Color fundus image, 2048x1536px, 45-degree field of view
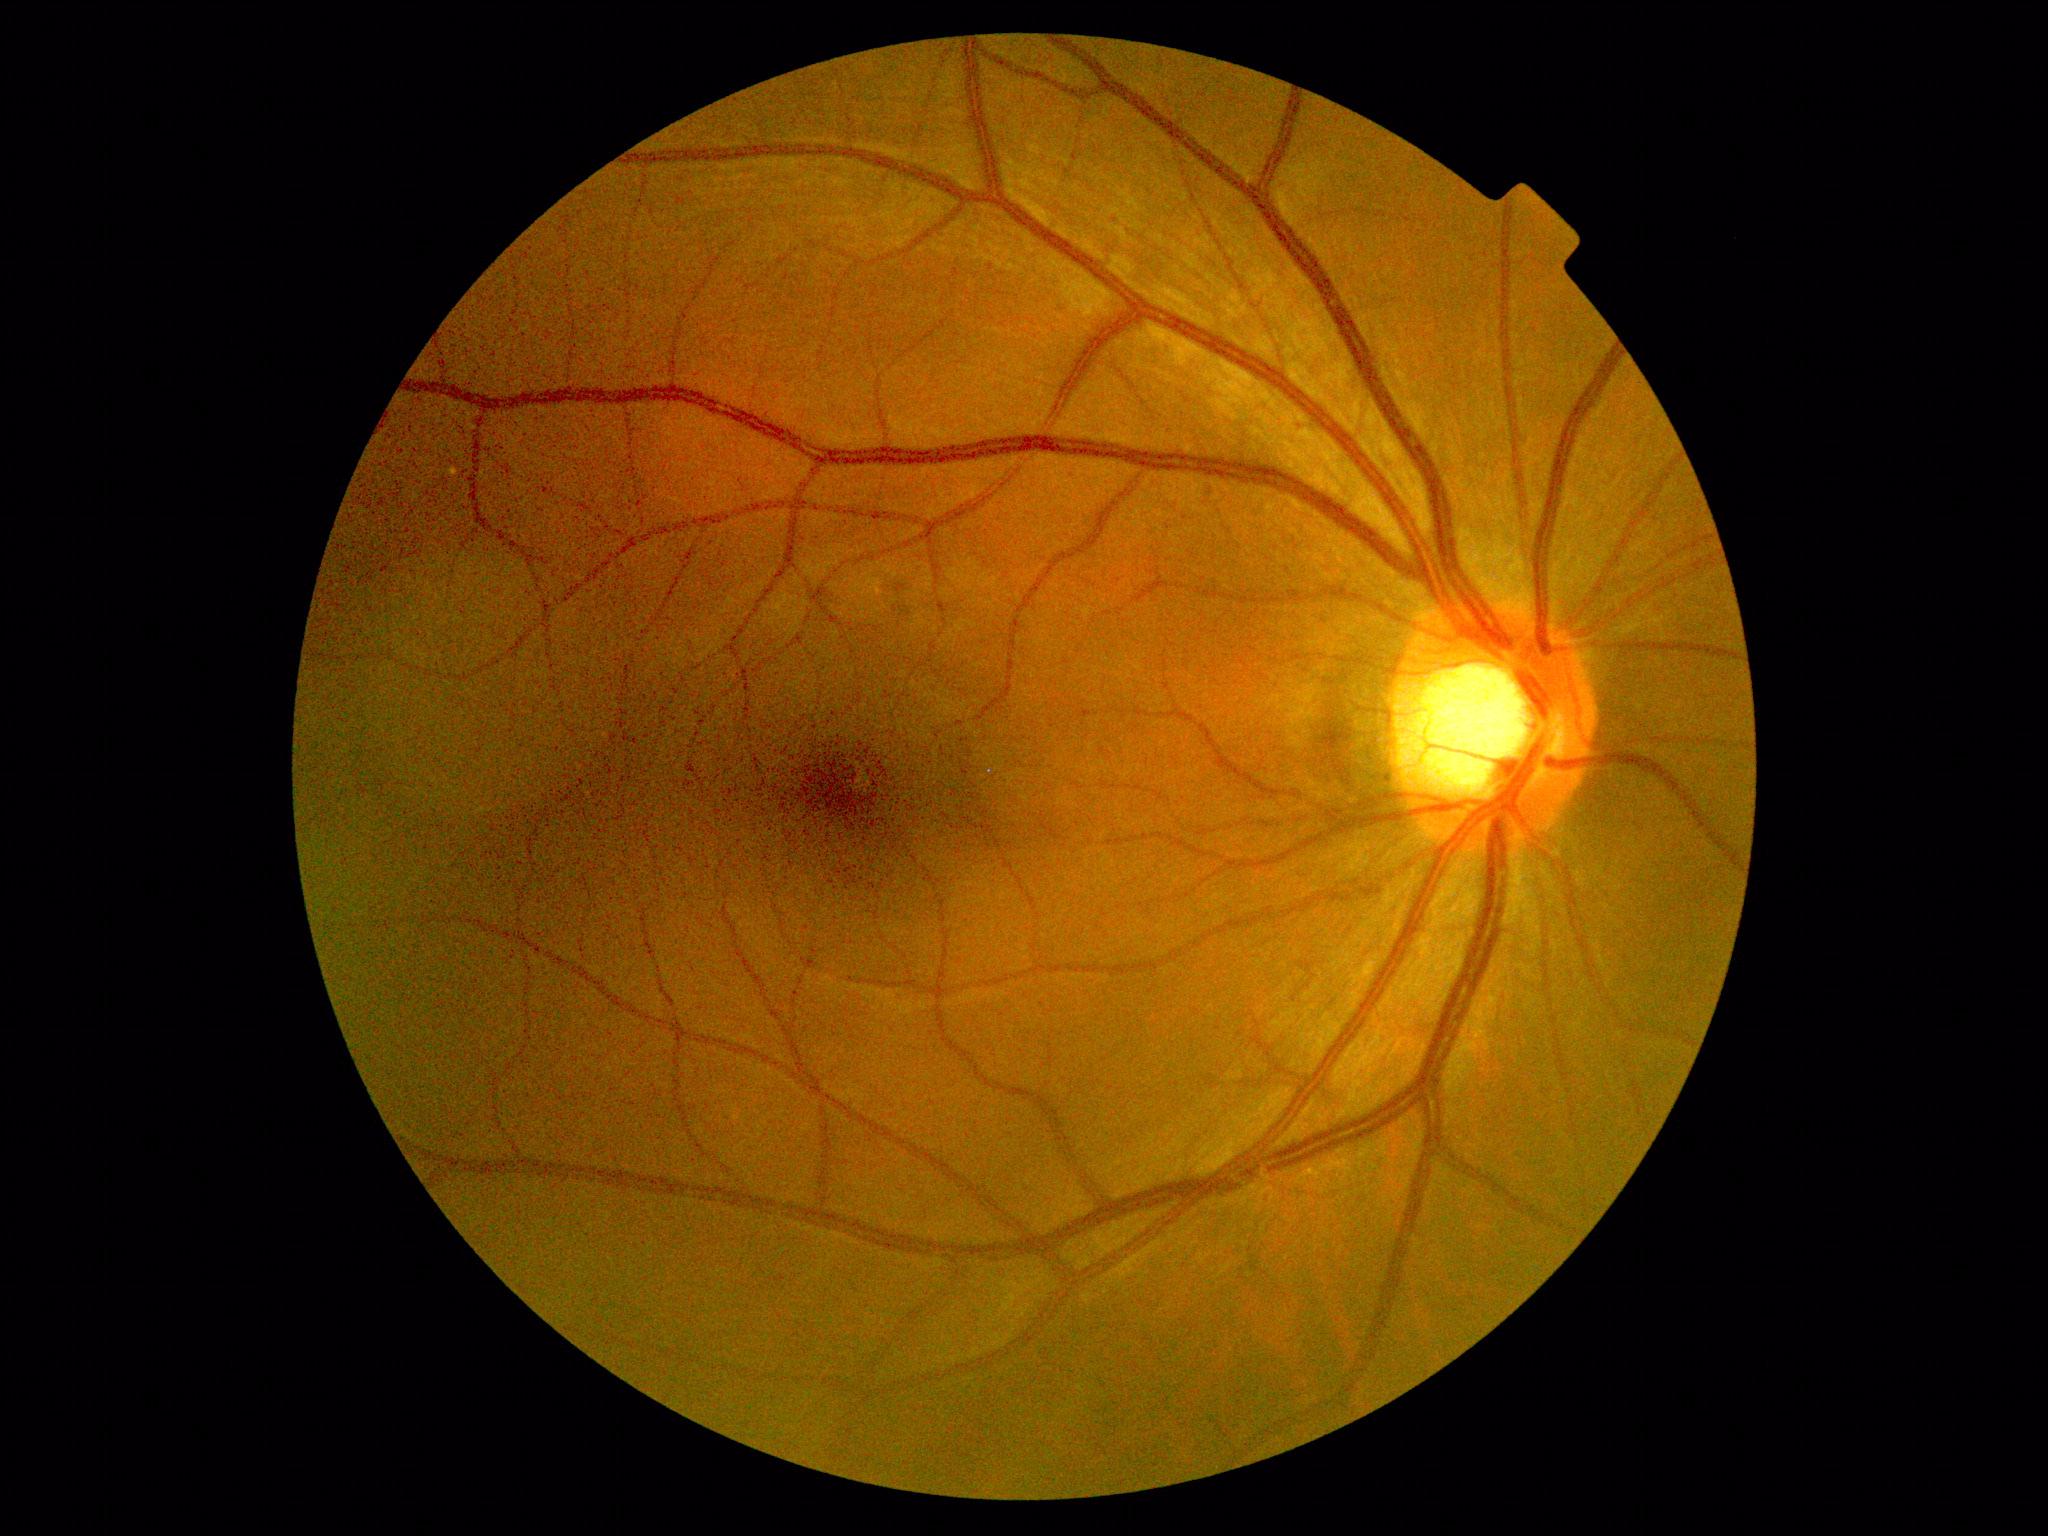 No apparent diabetic retinopathy. Diabetic retinopathy: no apparent diabetic retinopathy (grade 0).